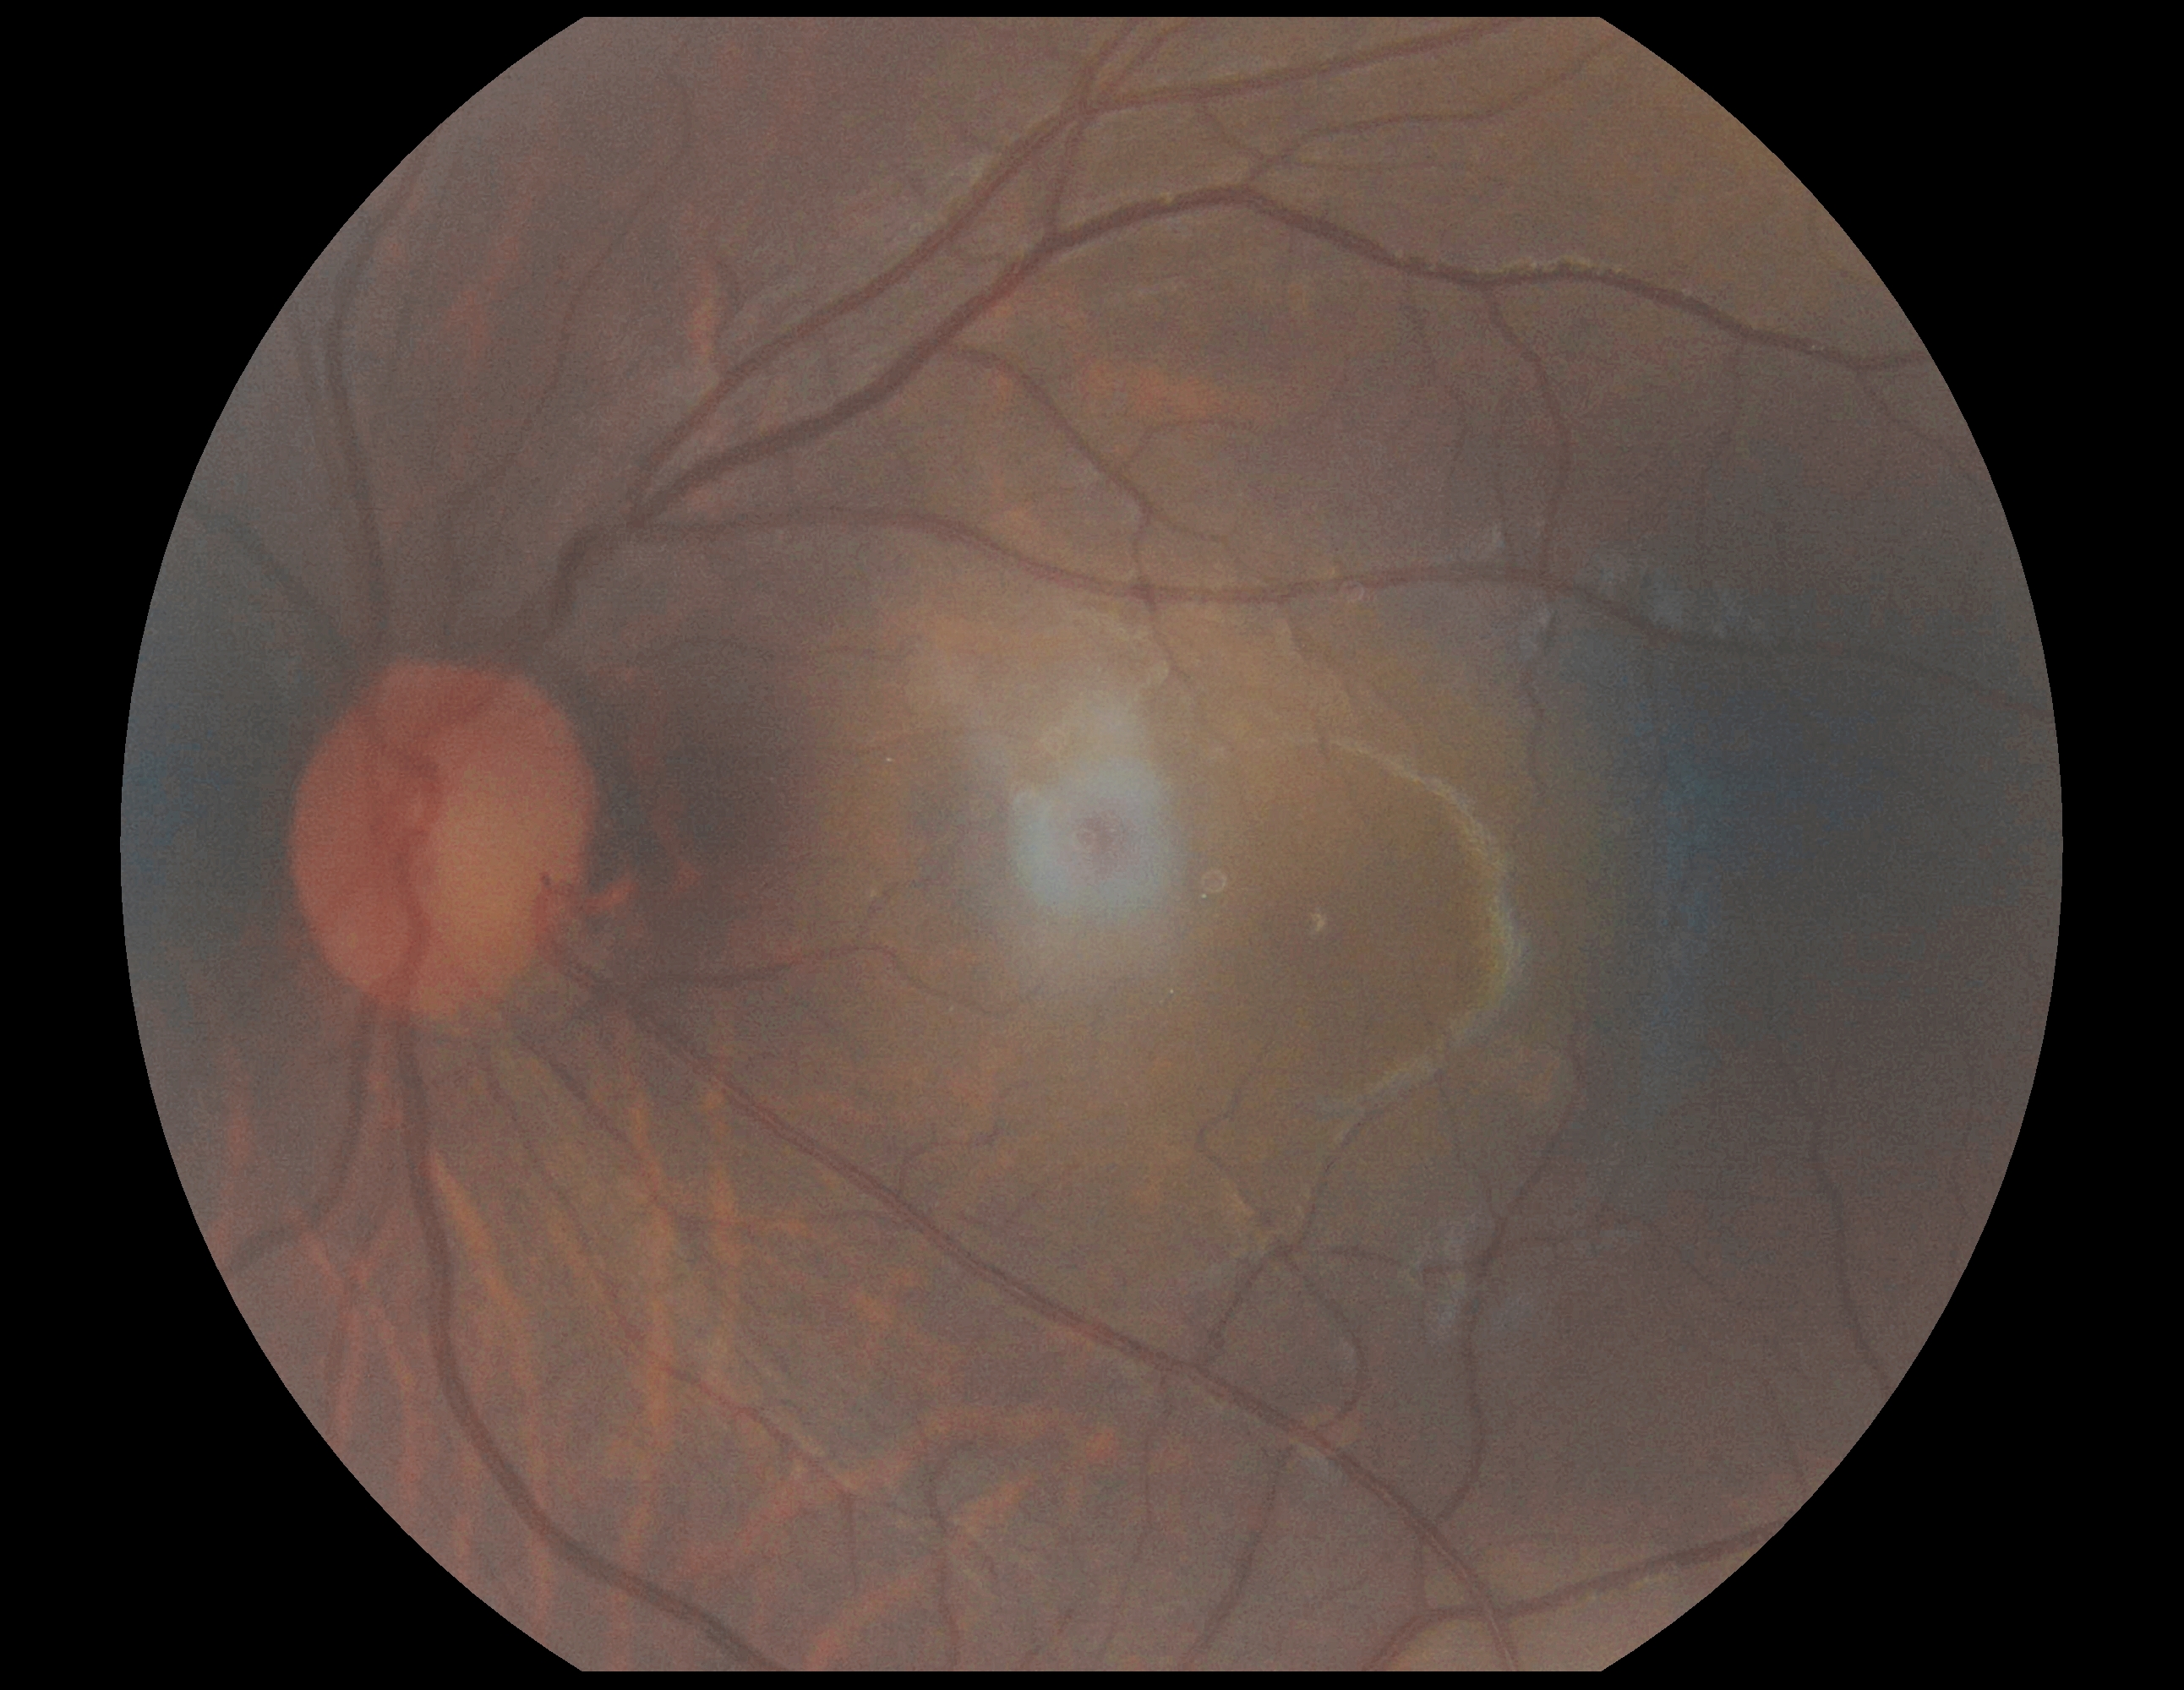 retinopathy grade=0 — no visible signs of diabetic retinopathy.